Without pupil dilation:
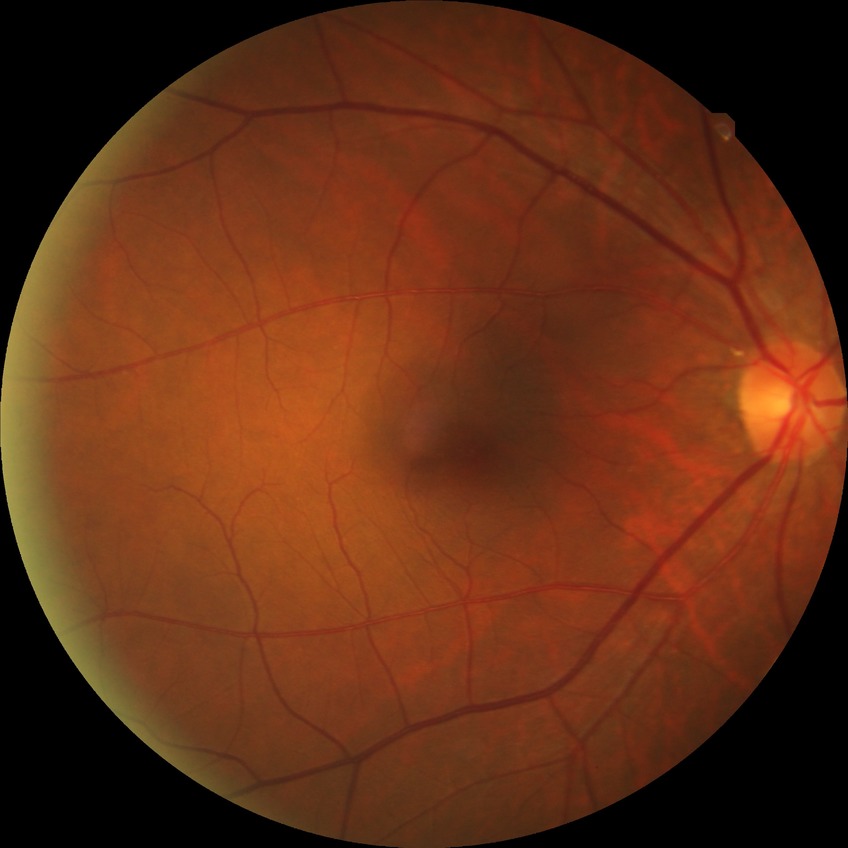

Annotations:
• diabetic retinopathy (DR) — no diabetic retinopathy (NDR)